45° FOV, 1932 x 1916 pixels: 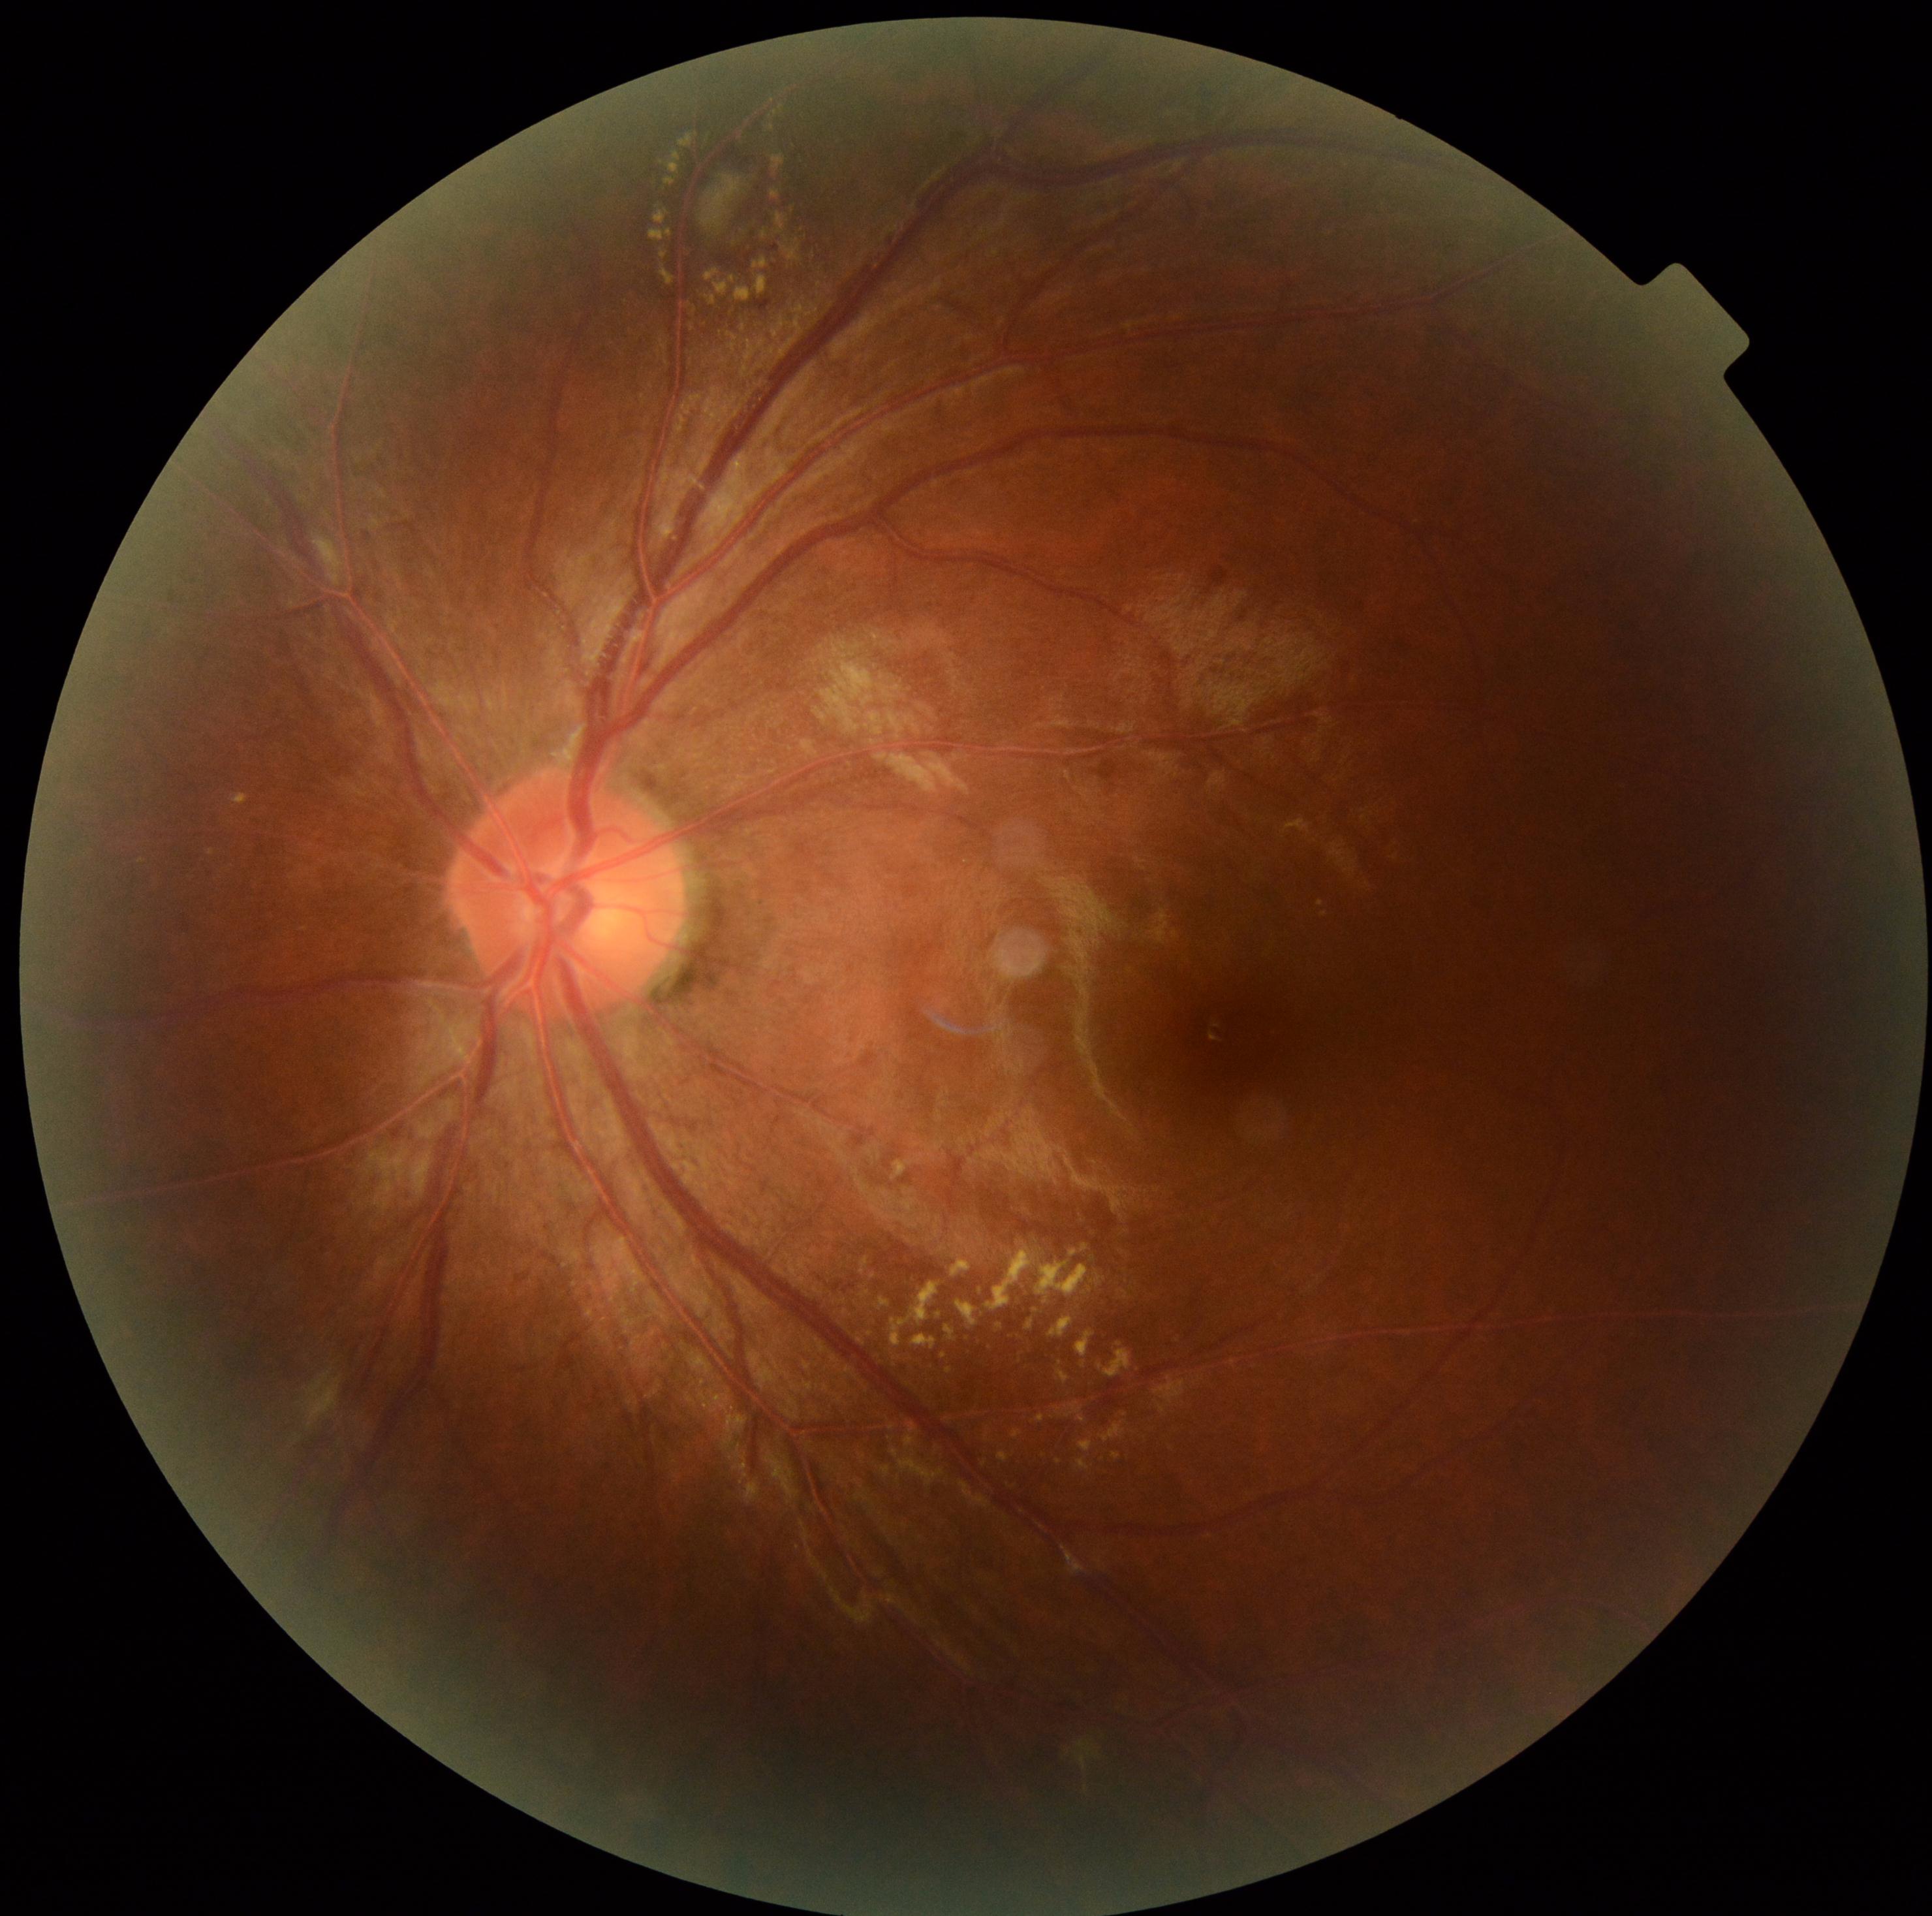

Diabetic retinopathy severity is moderate non-proliferative diabetic retinopathy (grade 2).